240x240px; non-mydriatic acquisition:
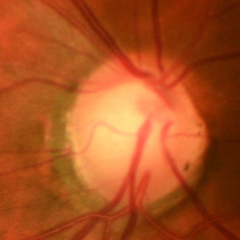

Glaucoma status = early glaucomatous optic neuropathy. Diagnostic criteria: glaucomatous retinal nerve fiber layer defects on red-free fundus photography without visual field defects.